Davis DR grading — 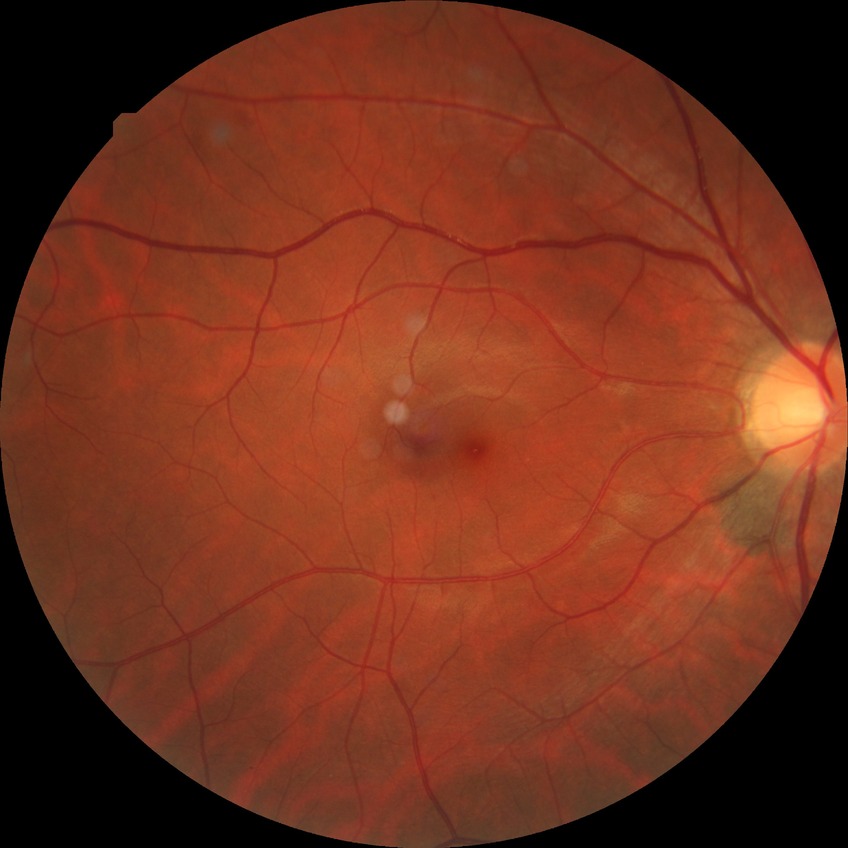

No DR findings. DR stage is NDR.